Color fundus photograph. 848x848. Without pupil dilation
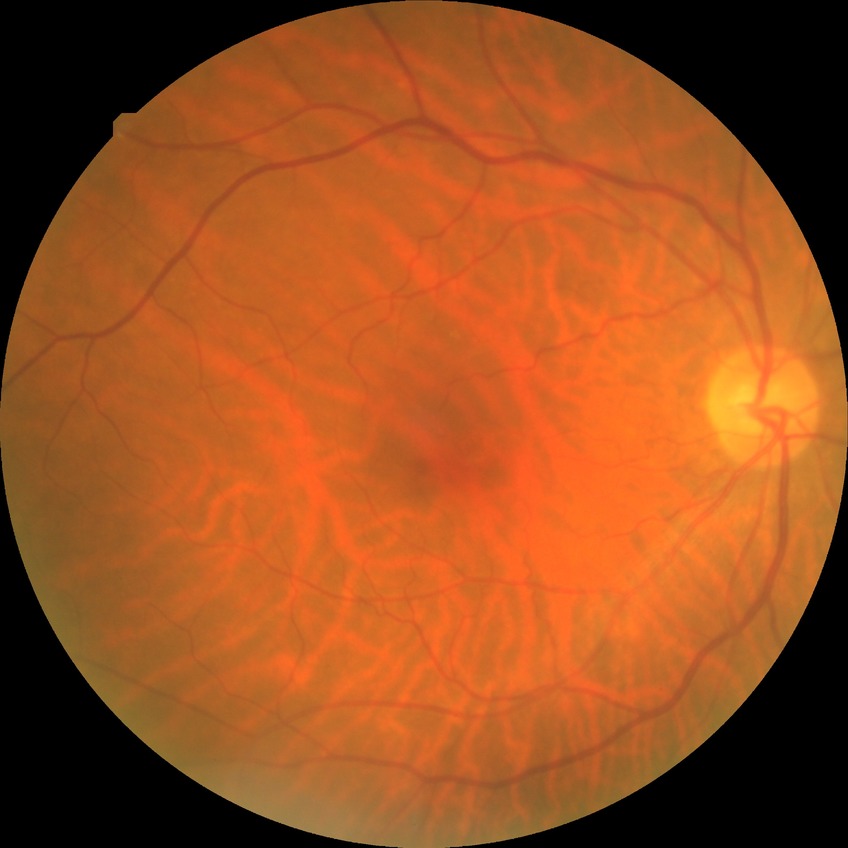

Diabetic retinopathy (DR): no diabetic retinopathy (NDR).